2228x1652px; FOV: 50 degrees; color fundus photograph — 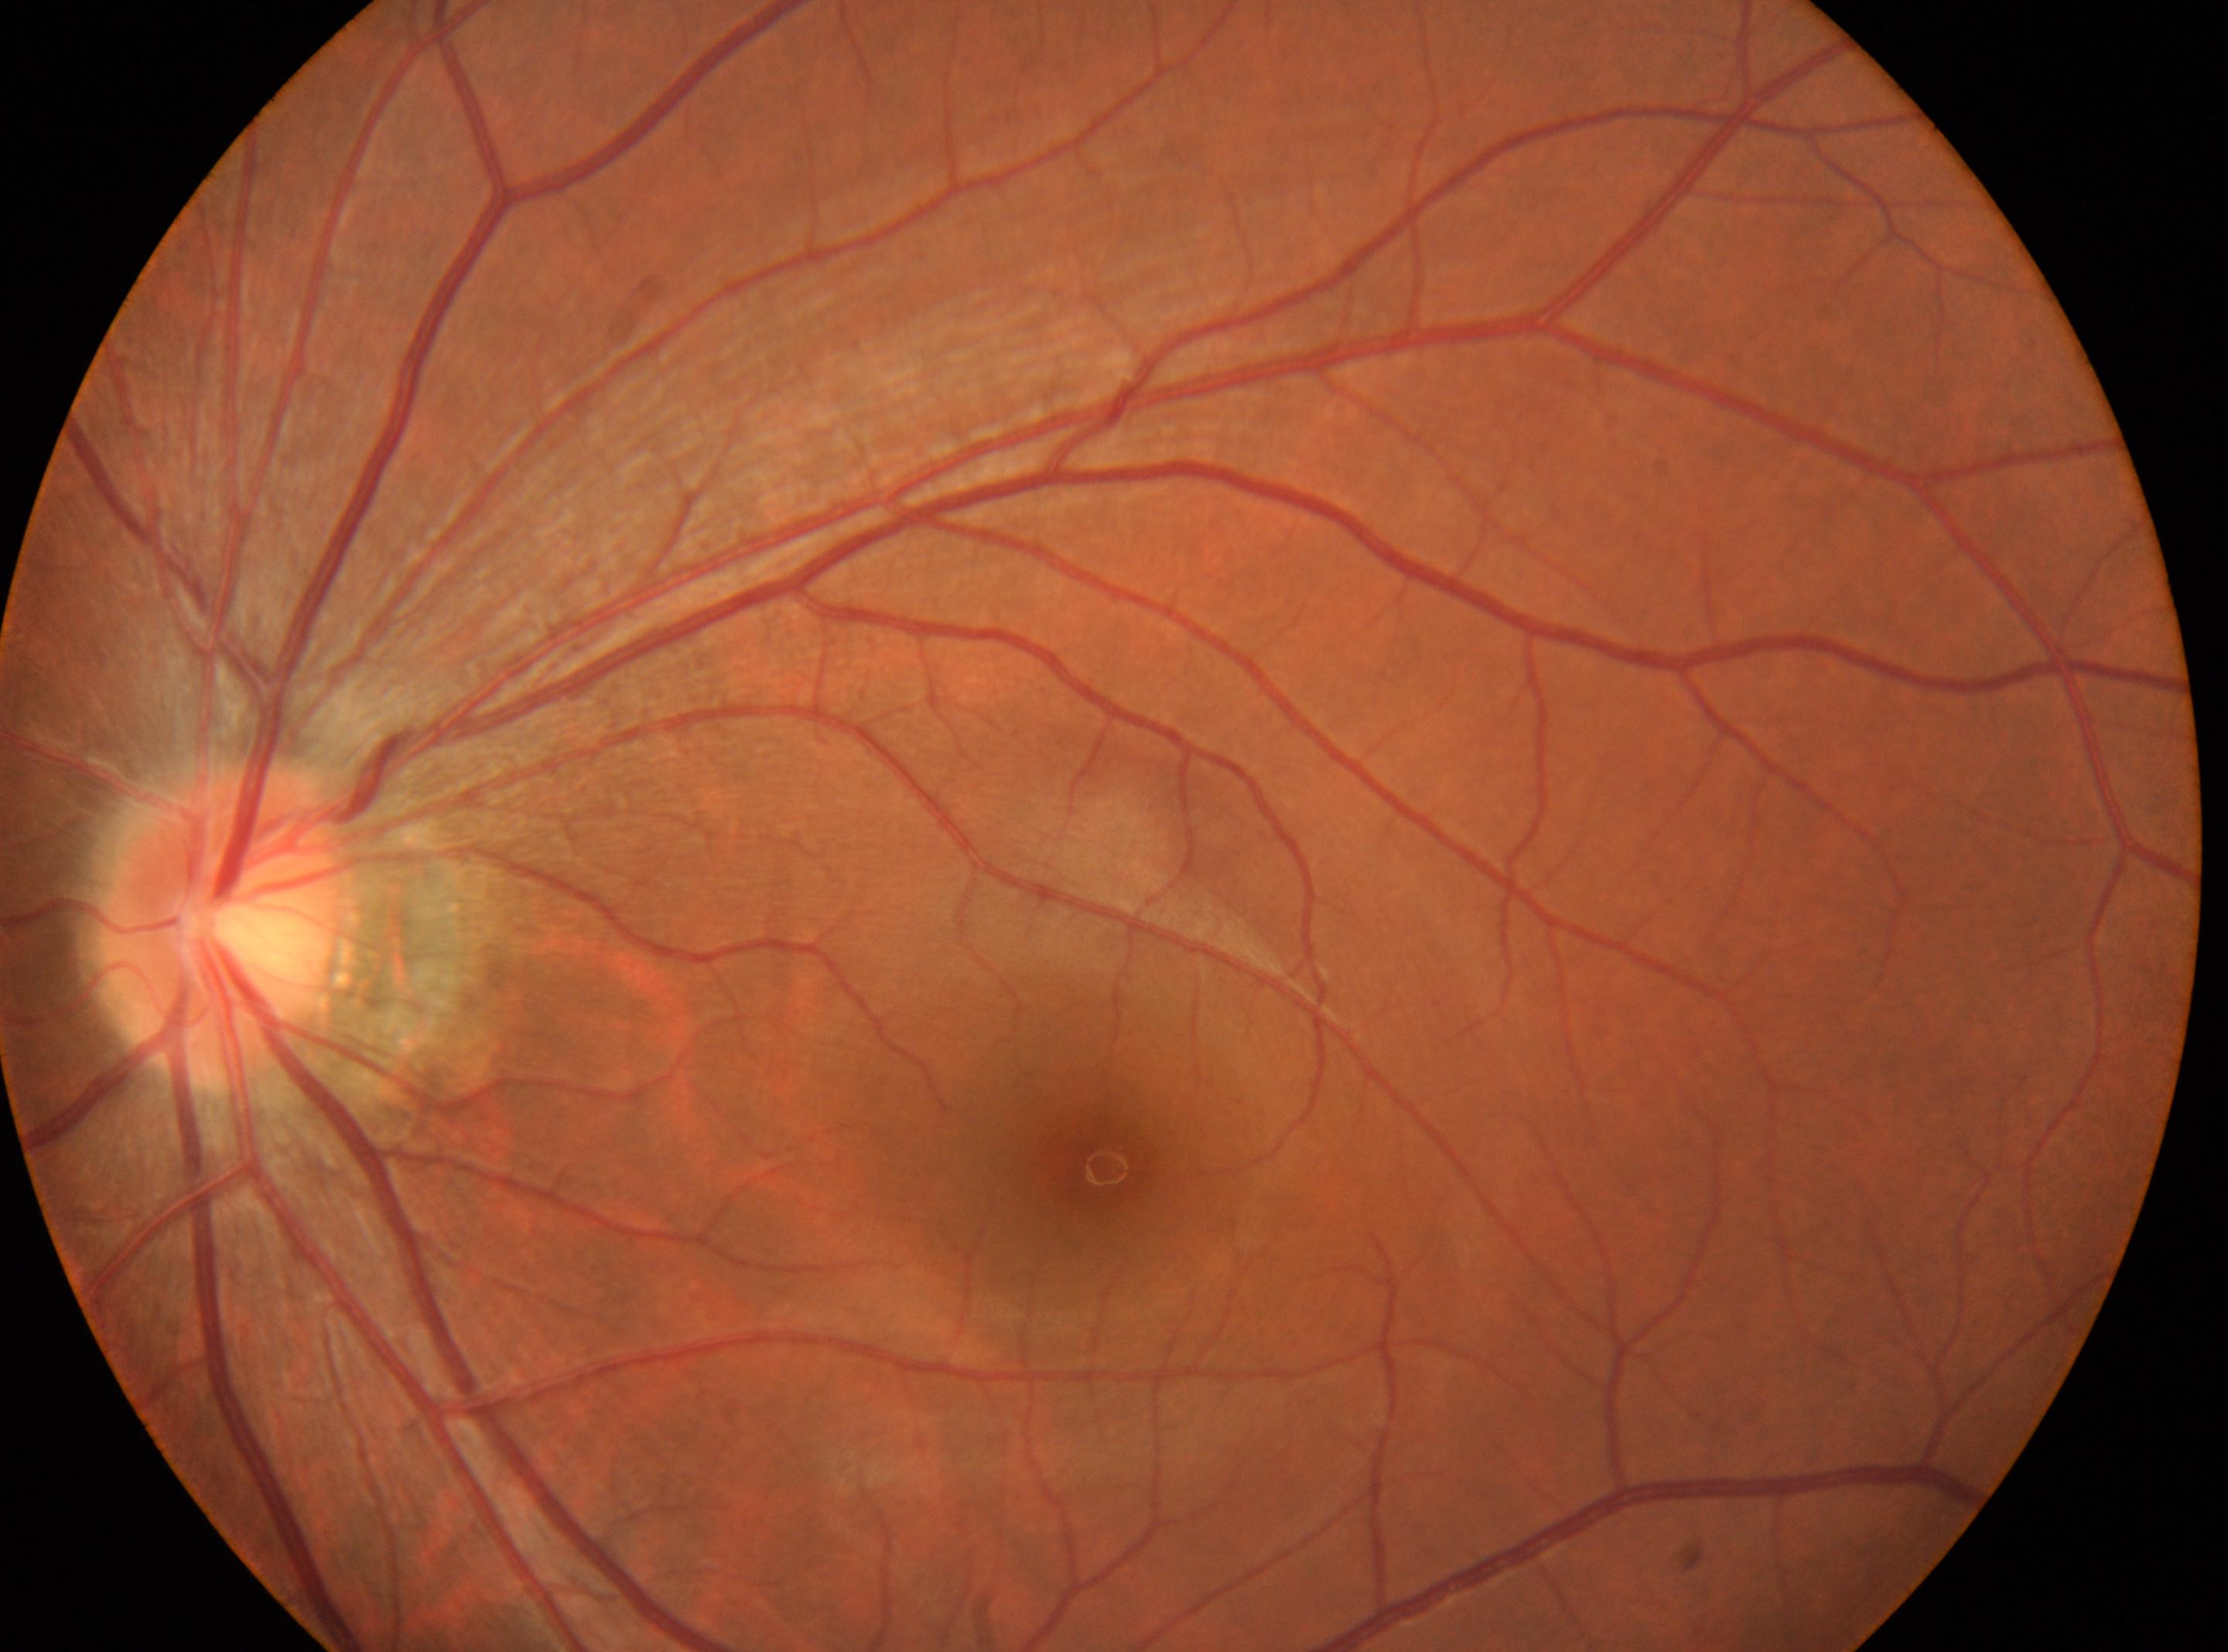

Foveal center: (x: 1102, y: 1166). Diabetic retinopathy (DR) is grade 0 — no visible signs of diabetic retinopathy. The disc center is at (x: 221, y: 926). Eye: left eye.